RetCam wide-field infant fundus image. Camera: Clarity RetCam 3 (130° FOV).
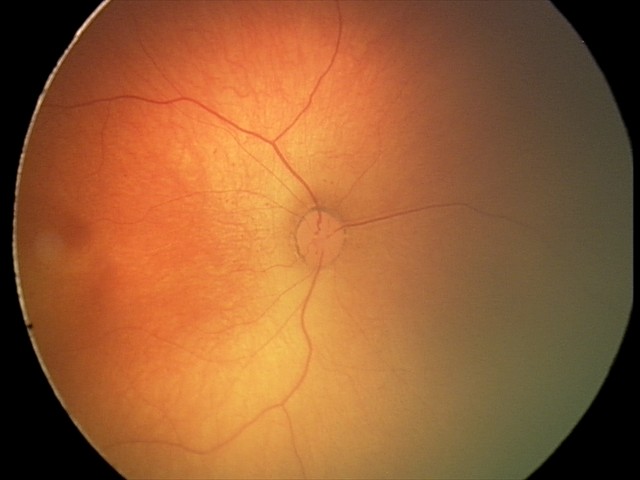
Diagnosis: normal retinal appearance.